CFP; graded on the modified Davis scale; nonmydriatic fundus photograph — 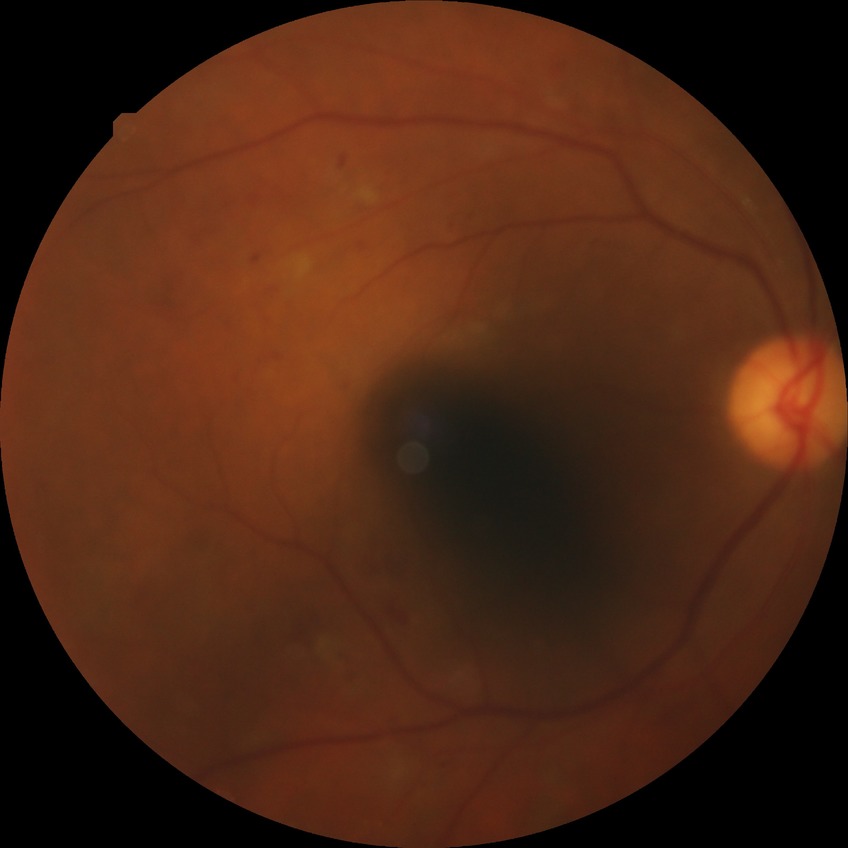

diabetic retinopathy (DR): pre-proliferative diabetic retinopathy (PPDR).